Fundus photo; image size 2212x1659 — 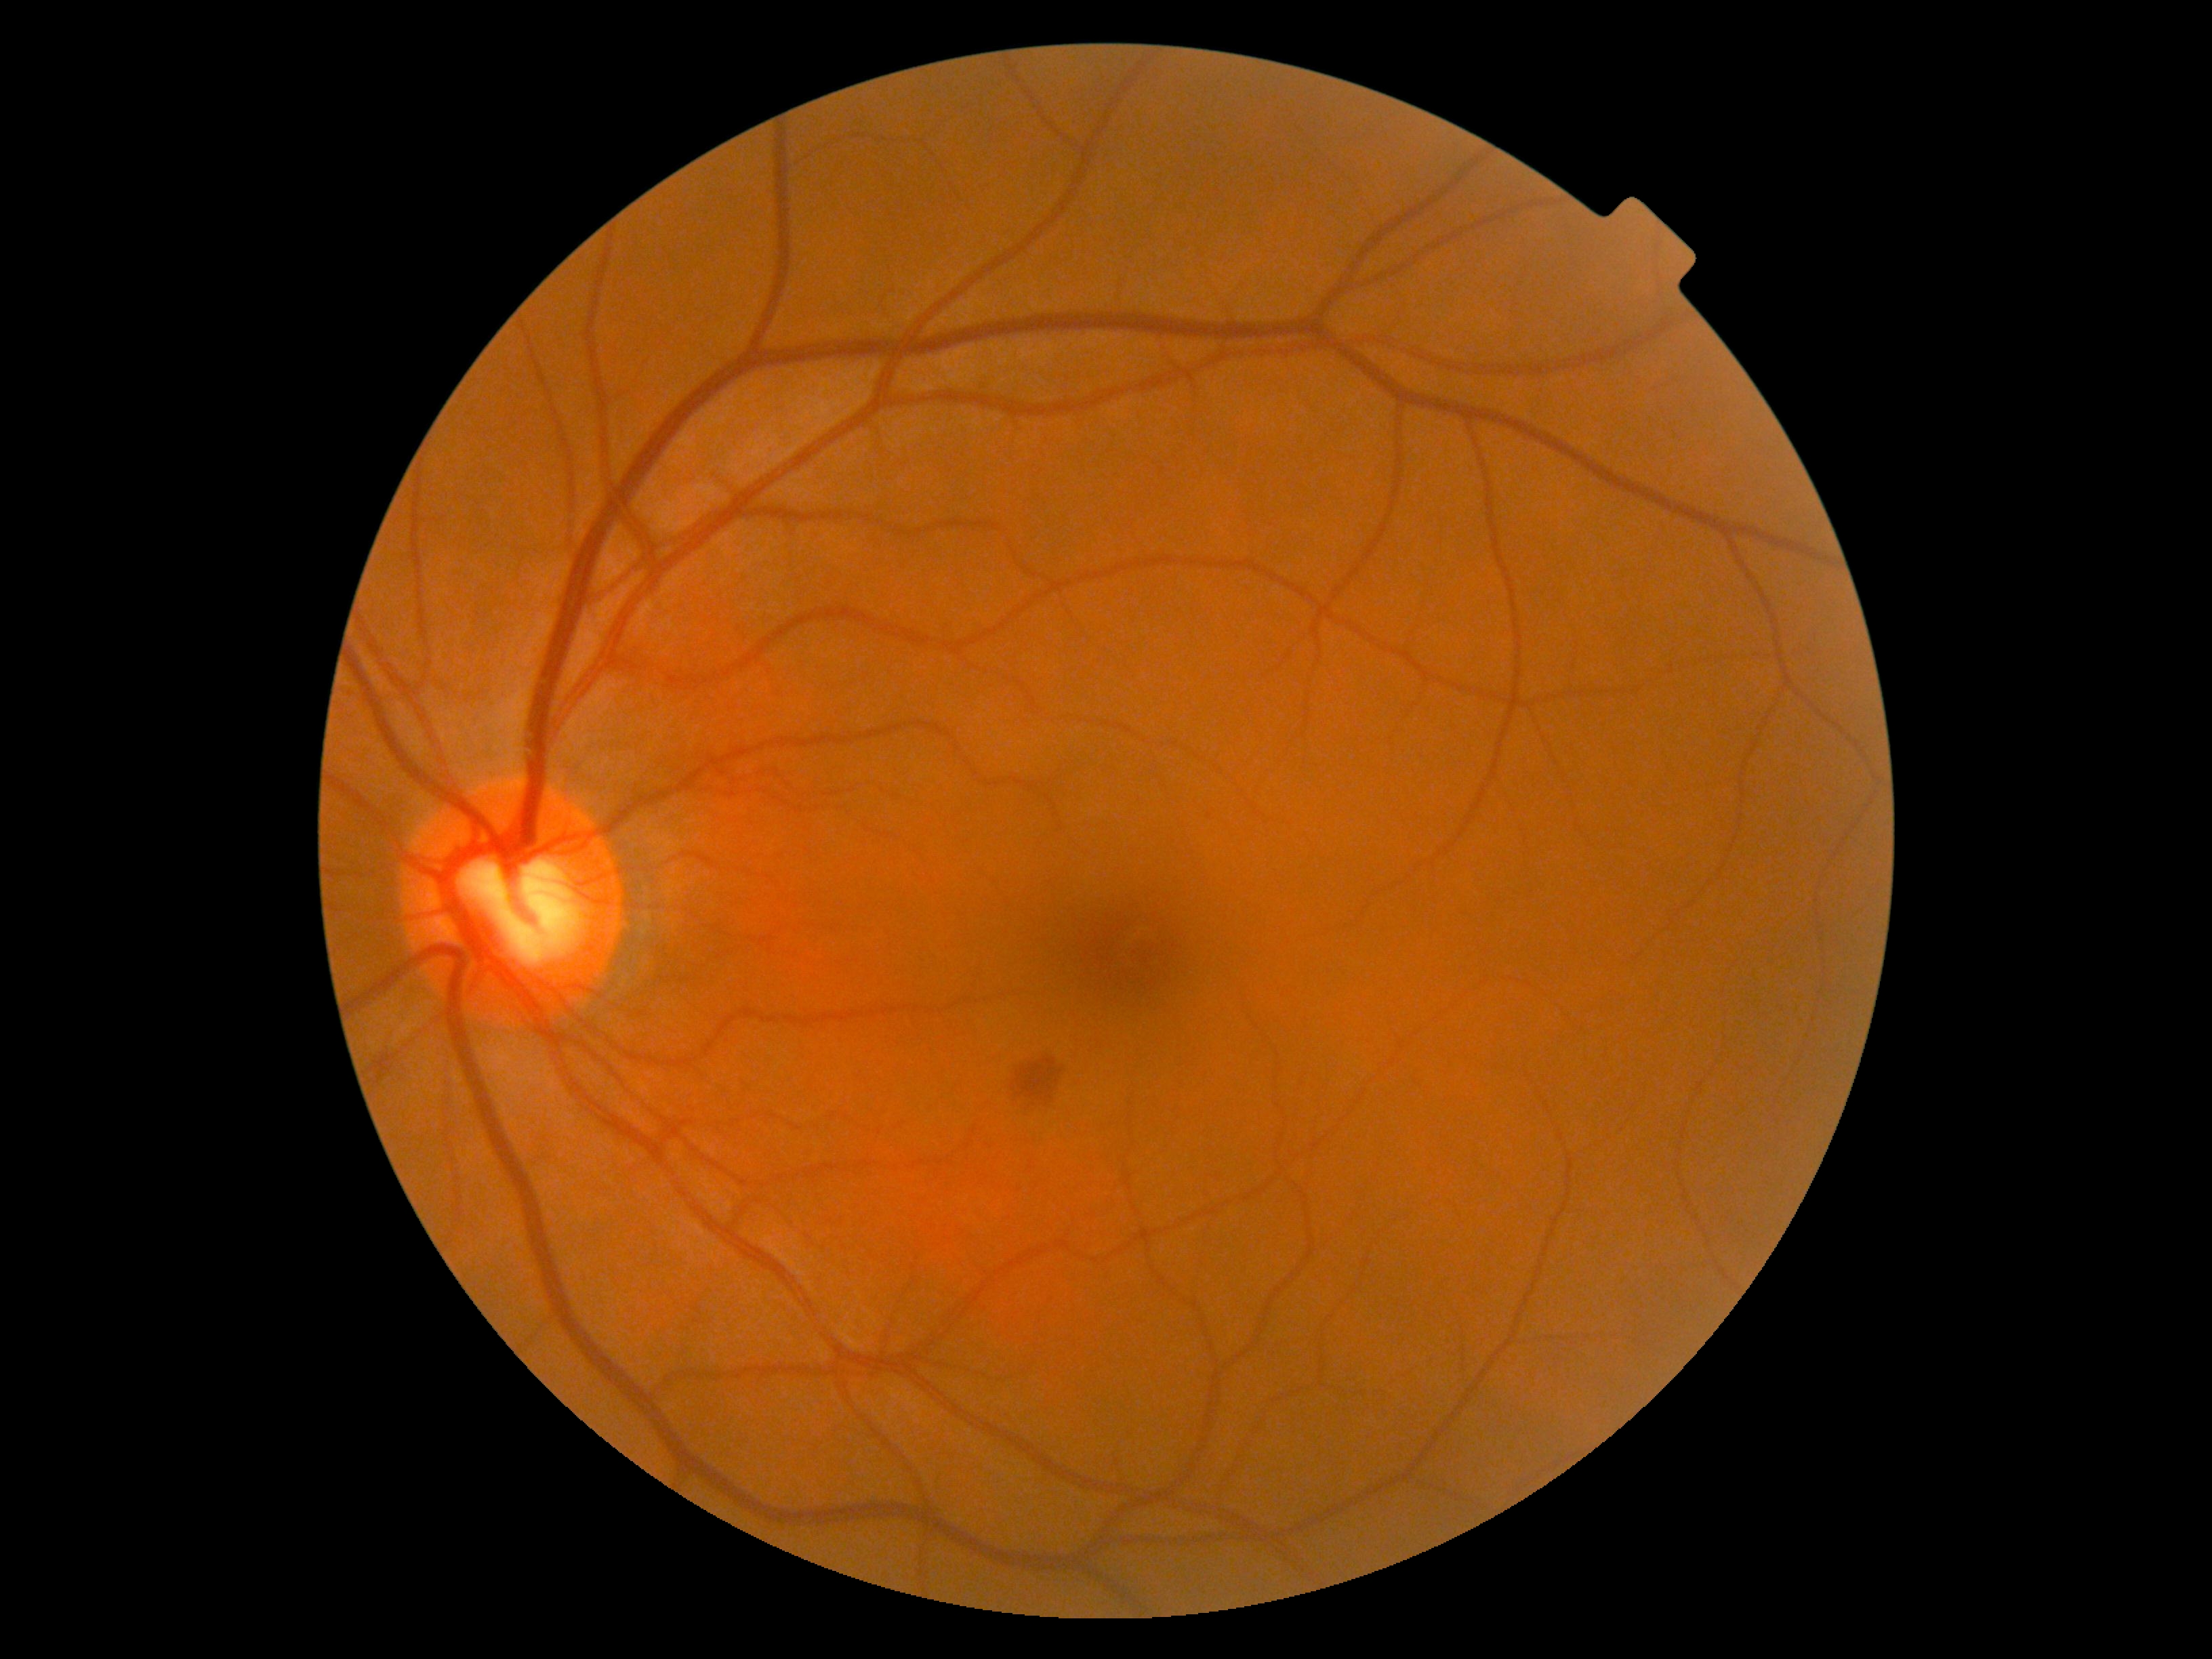 {"dr_grade": "moderate NPDR (grade 2)"}